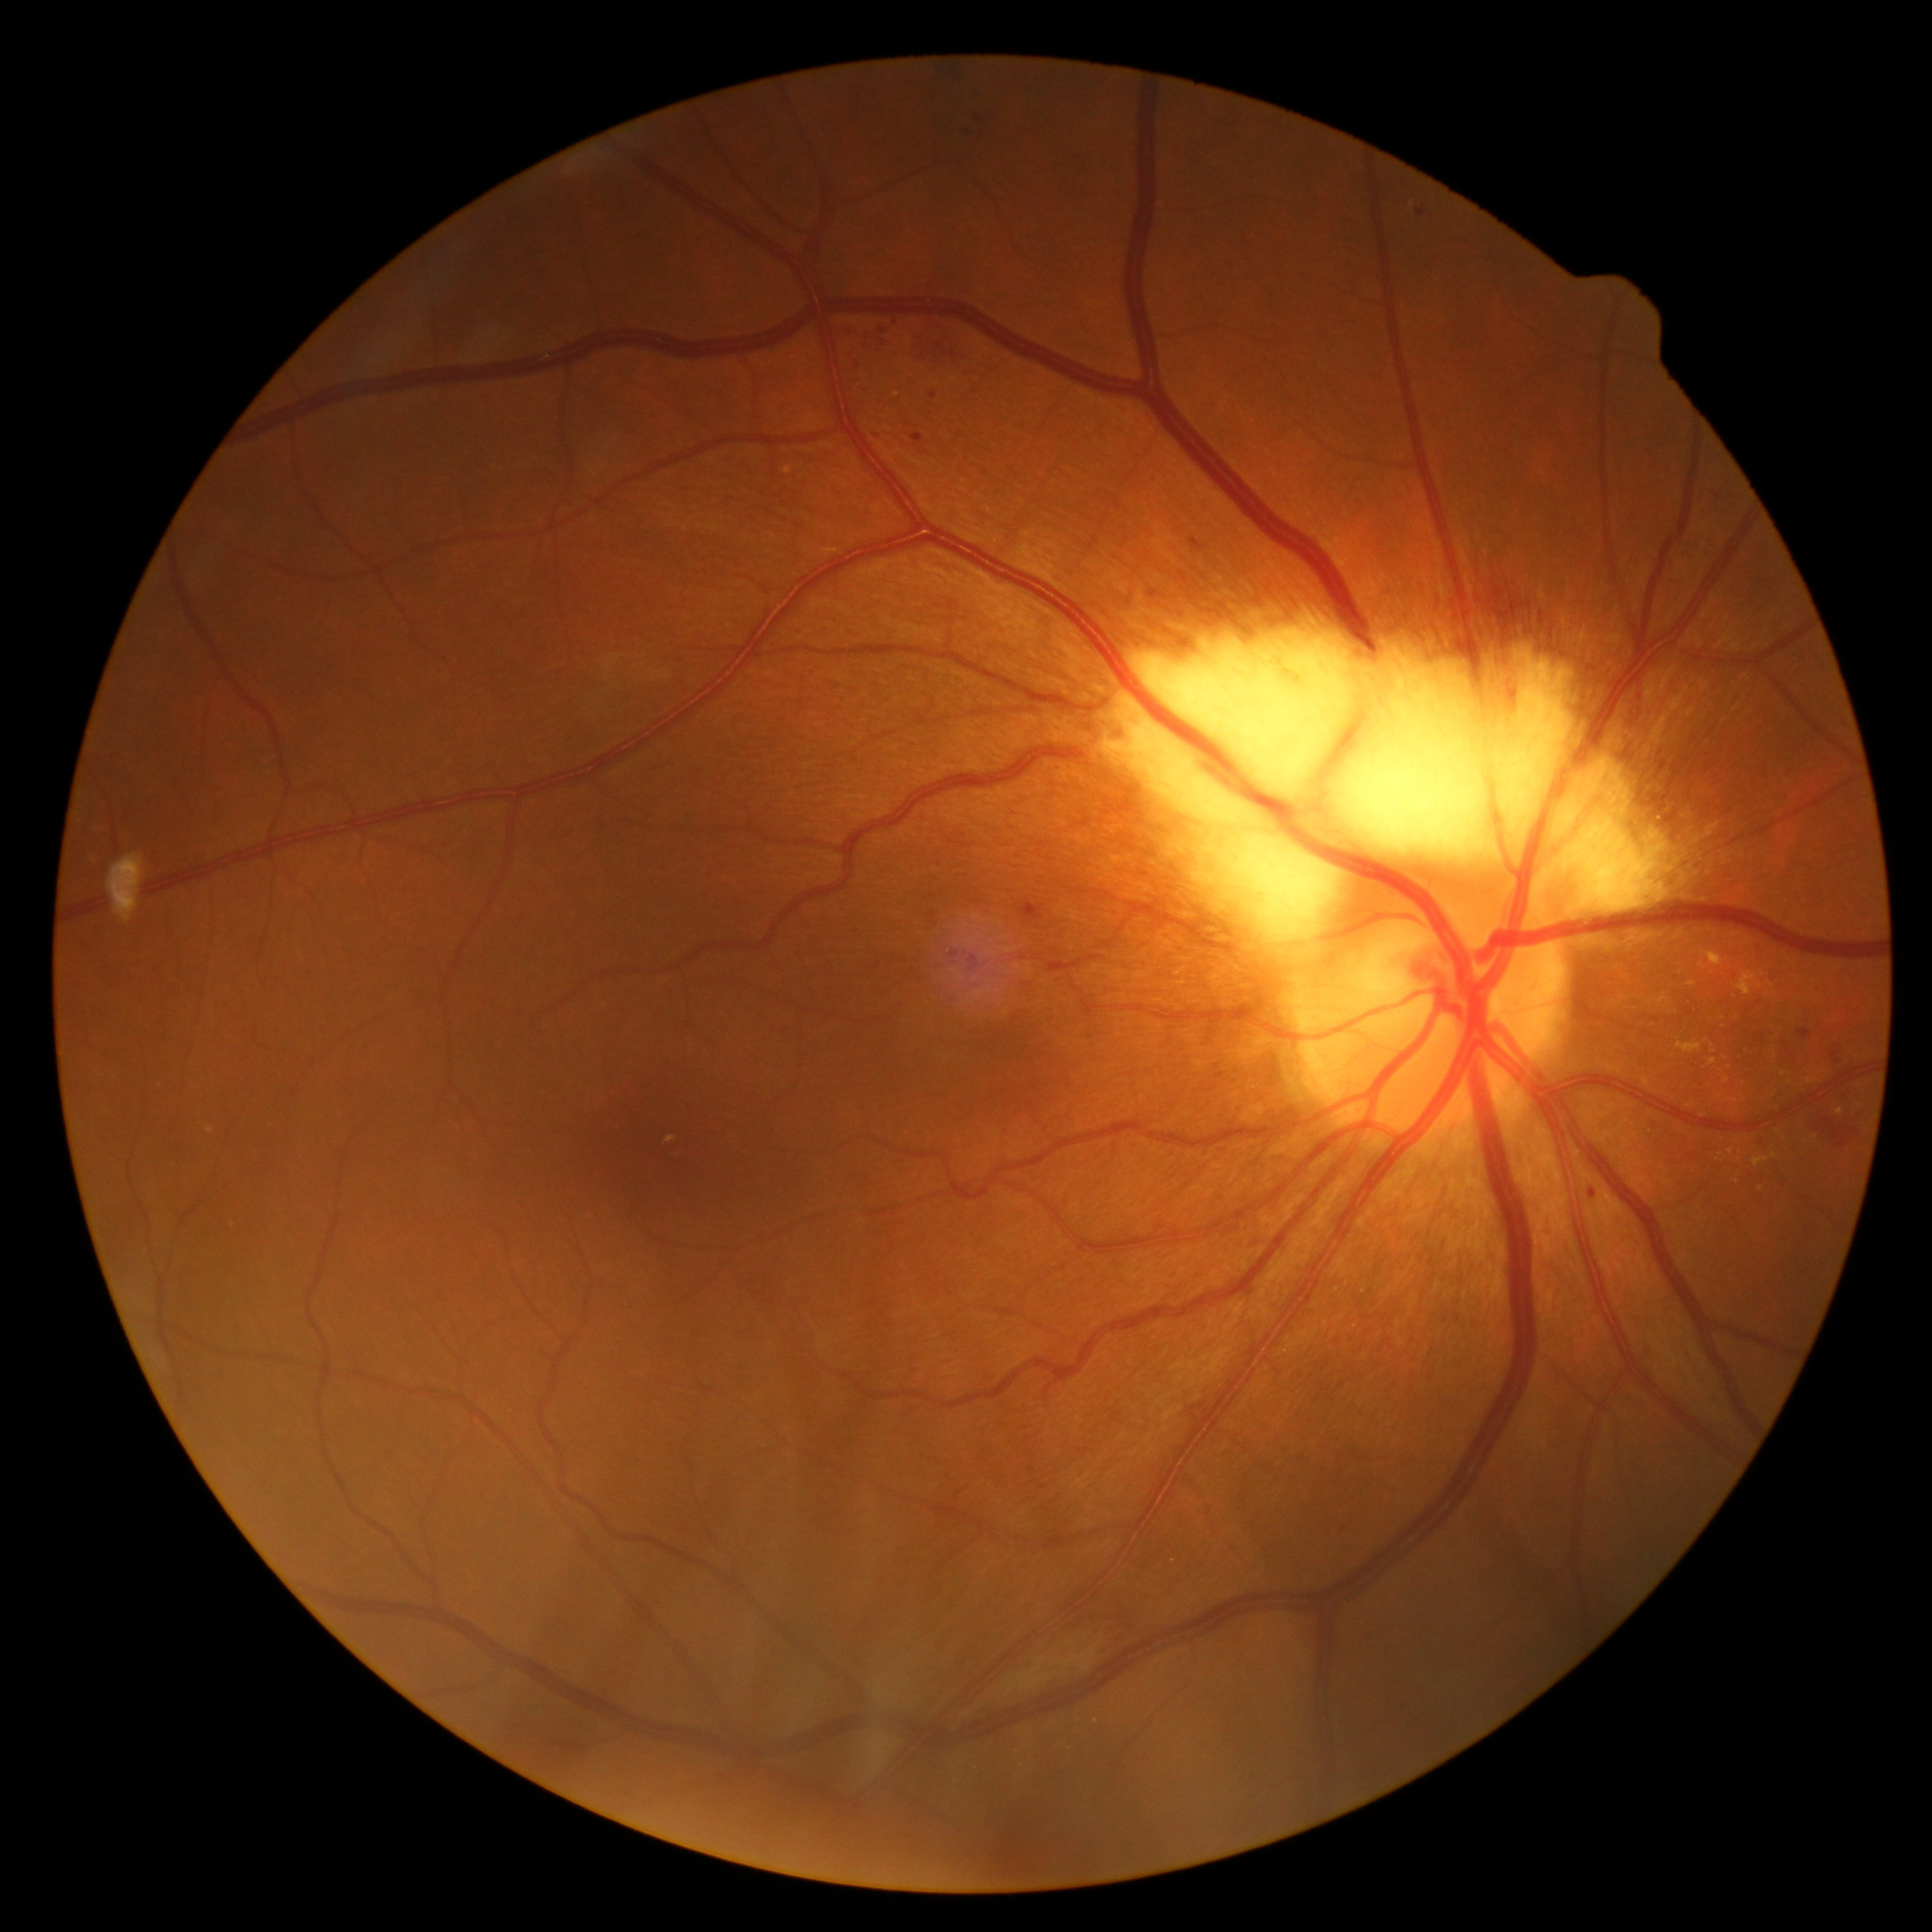 <lesions partial="true">
  <dr_grade>2</dr_grade>
  <ma>(left=1589, top=1190, right=1596, bottom=1199) | (left=846, top=324, right=857, bottom=336) | (left=855, top=356, right=866, bottom=372) | (left=967, top=131, right=974, bottom=141) | (left=910, top=433, right=923, bottom=443) | (left=970, top=956, right=979, bottom=967) | (left=1020, top=904, right=1044, bottom=922) | (left=973, top=90, right=976, bottom=100) | (left=1797, top=1030, right=1810, bottom=1039) | (left=1191, top=539, right=1200, bottom=550) | (left=1149, top=590, right=1159, bottom=599) | (left=927, top=912, right=937, bottom=918) | (left=929, top=392, right=937, bottom=399) | (left=972, top=112, right=981, bottom=120)</ma>
  <ma_small>x=1835 y=1056 | x=883 y=331 | x=1839 y=1062 | x=955 y=955 | x=1421 y=212</ma_small>
  <ex partial="true">(left=1735, top=972, right=1767, bottom=996) | (left=1643, top=1078, right=1650, bottom=1086) | (left=1806, top=1078, right=1814, bottom=1084) | (left=1753, top=1158, right=1768, bottom=1167) | (left=1677, top=1043, right=1702, bottom=1054)</ex>
  <ex_small>x=1770 y=984 | x=1727 y=1080 | x=1714 y=1051 | x=1700 y=965 | x=1770 y=995 | x=1721 y=1019</ex_small>
  <se />
  <he>(left=1823, top=1116, right=1860, bottom=1149) | (left=913, top=319, right=969, bottom=365) | (left=942, top=65, right=969, bottom=84)</he>
  <he_small>x=1818 y=1128</he_small>
</lesions>